45-degree field of view, 1380 x 1382 pixels
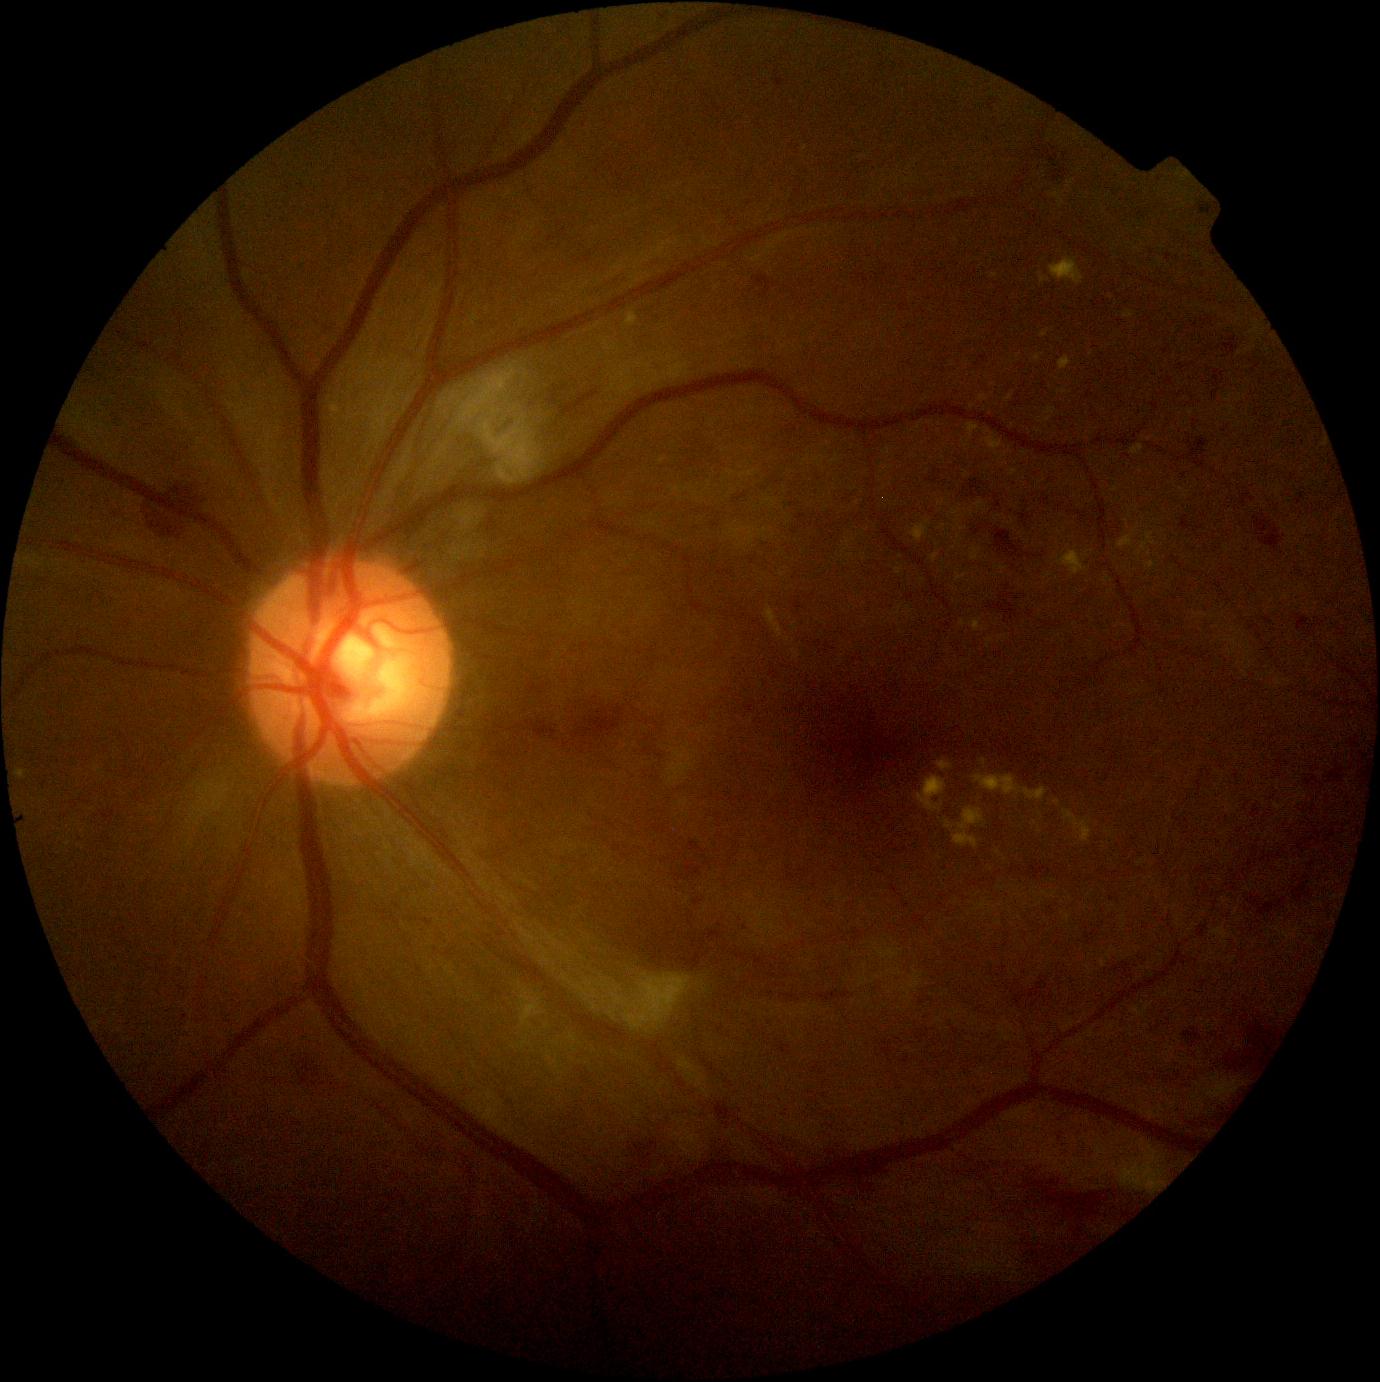
{"dr_grade": "grade 2"}